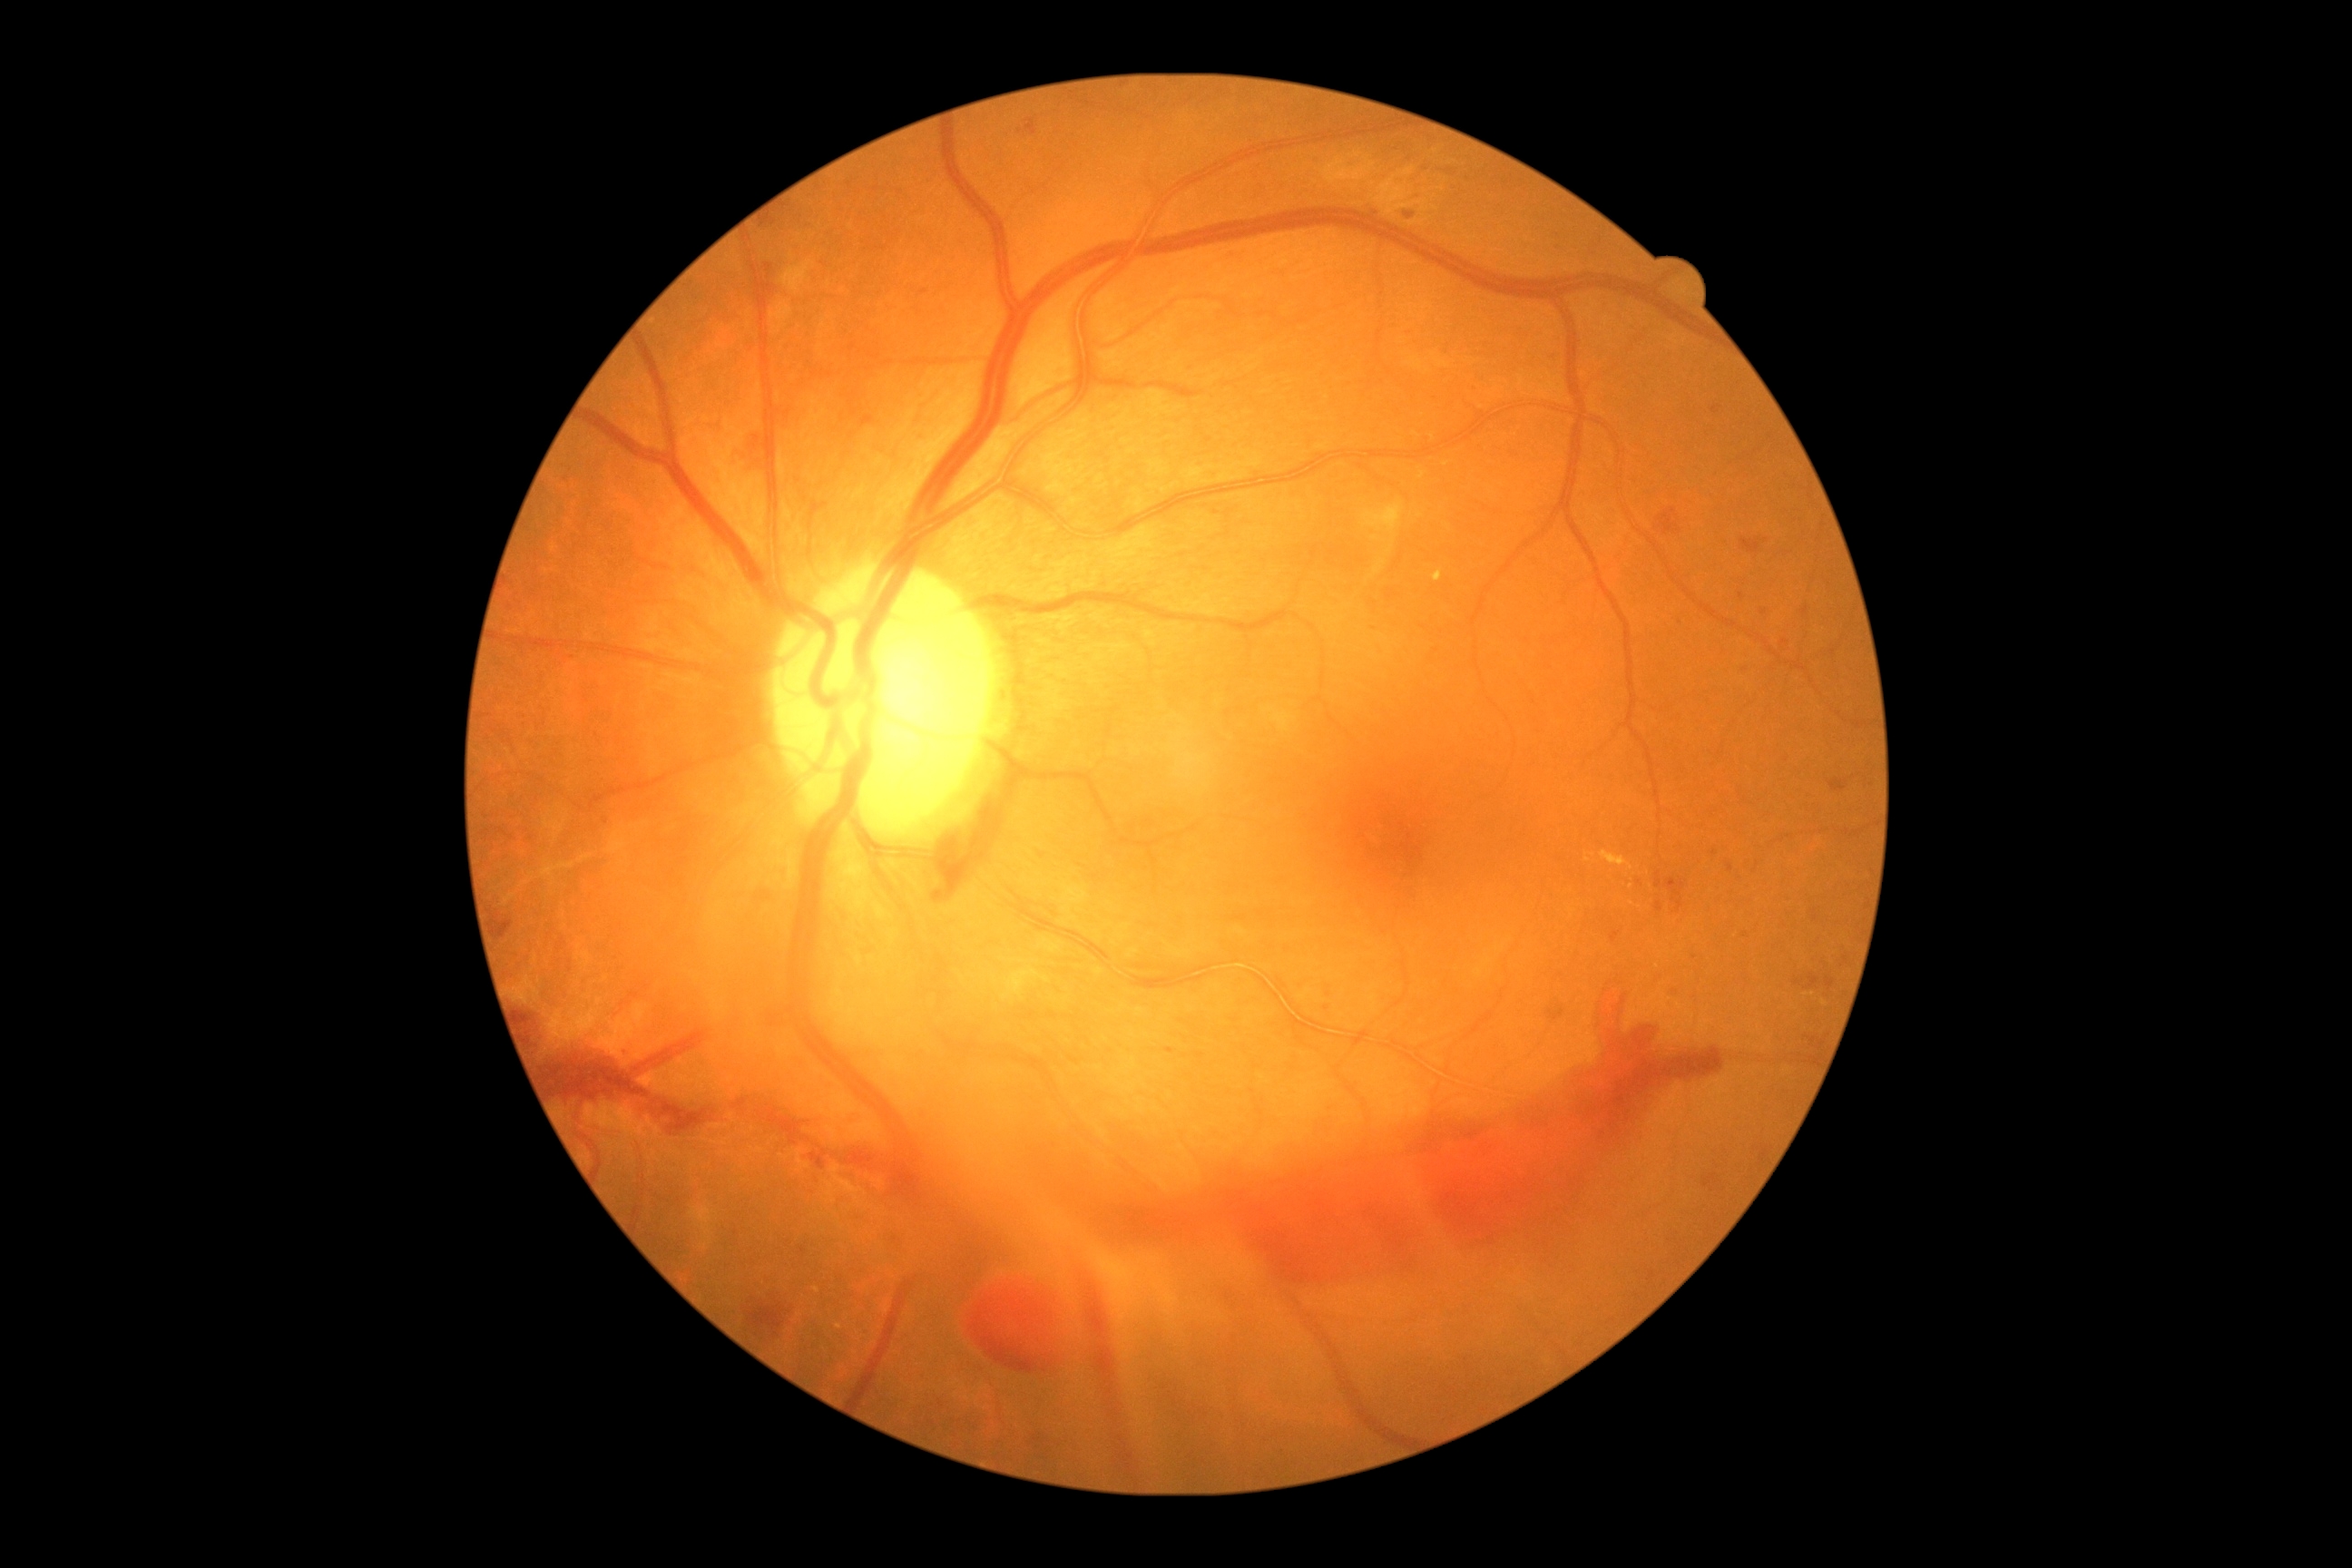

Annotations:
- diabetic retinopathy (DR) — grade 4 (PDR)